Pupil-dilated, fundus photo, 50-degree field of view, acquired with a Topcon TRC-50DX, 2228 by 1652 pixels, posterior pole view:
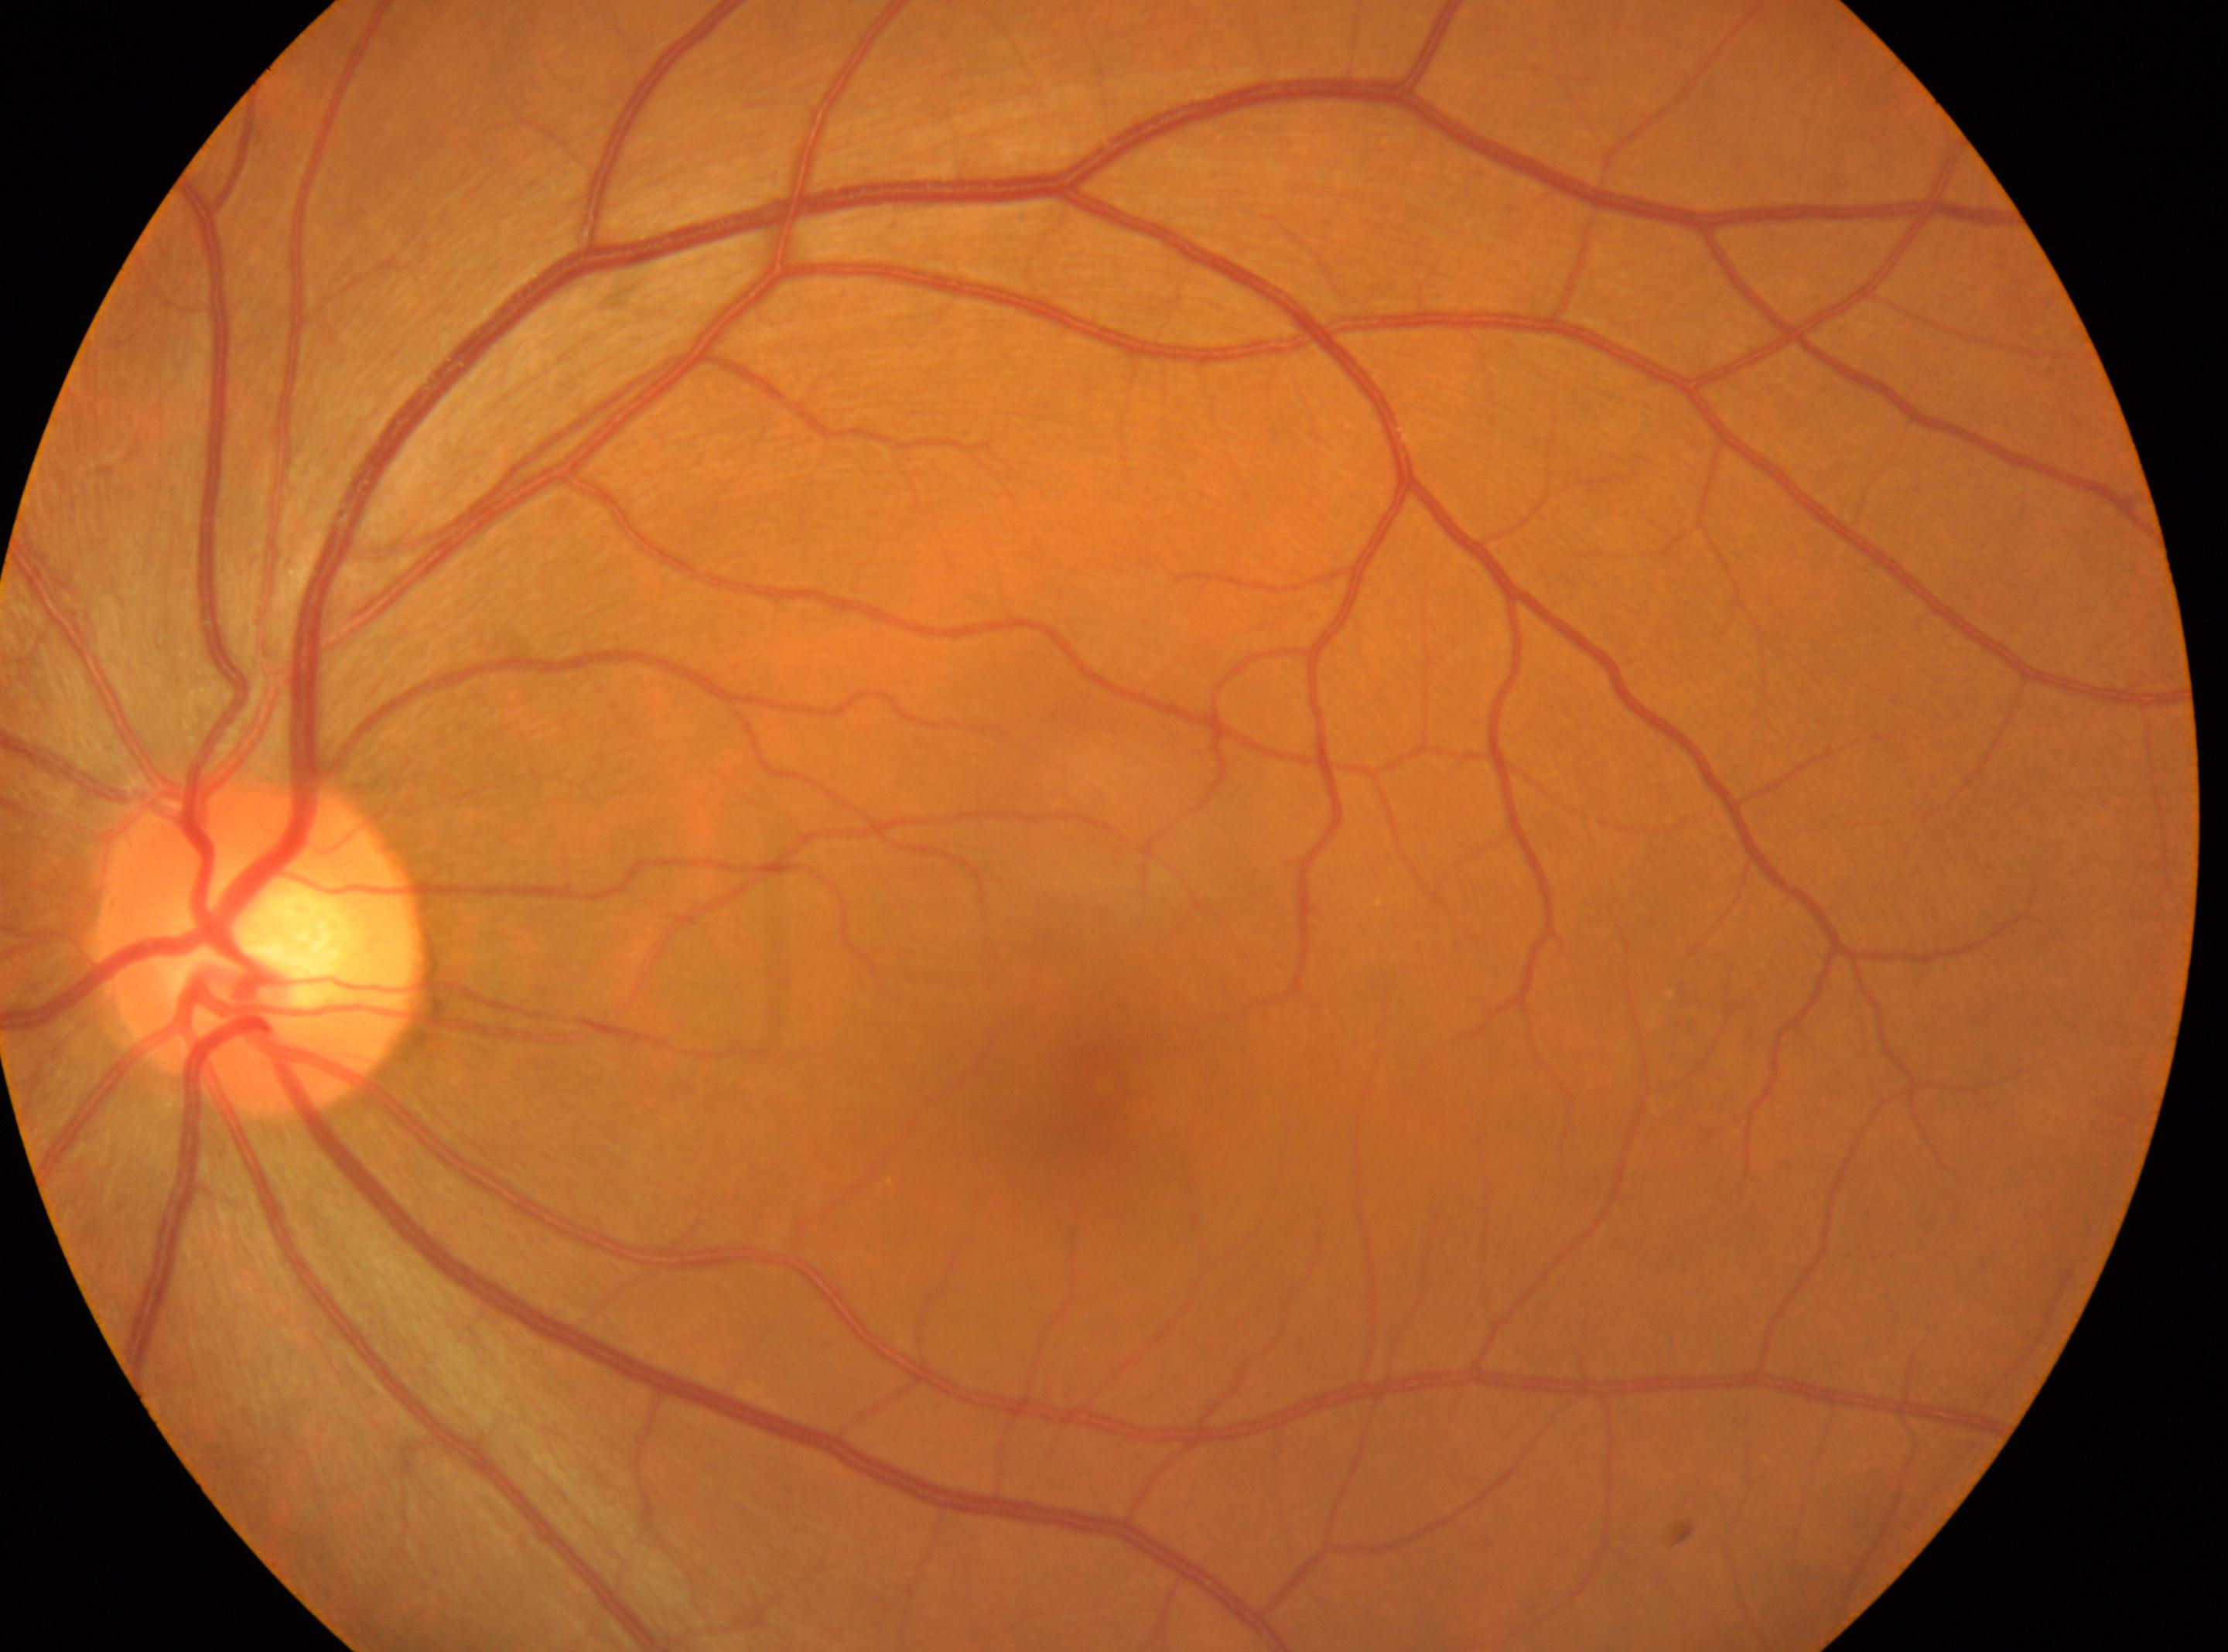 Optic disc center located at (259,945). Diabetic retinopathy severity is 0/4 — no visible signs of diabetic retinopathy. This is the left eye. Fovea located at (1092,1081).